45° field of view. Posterior pole photograph.
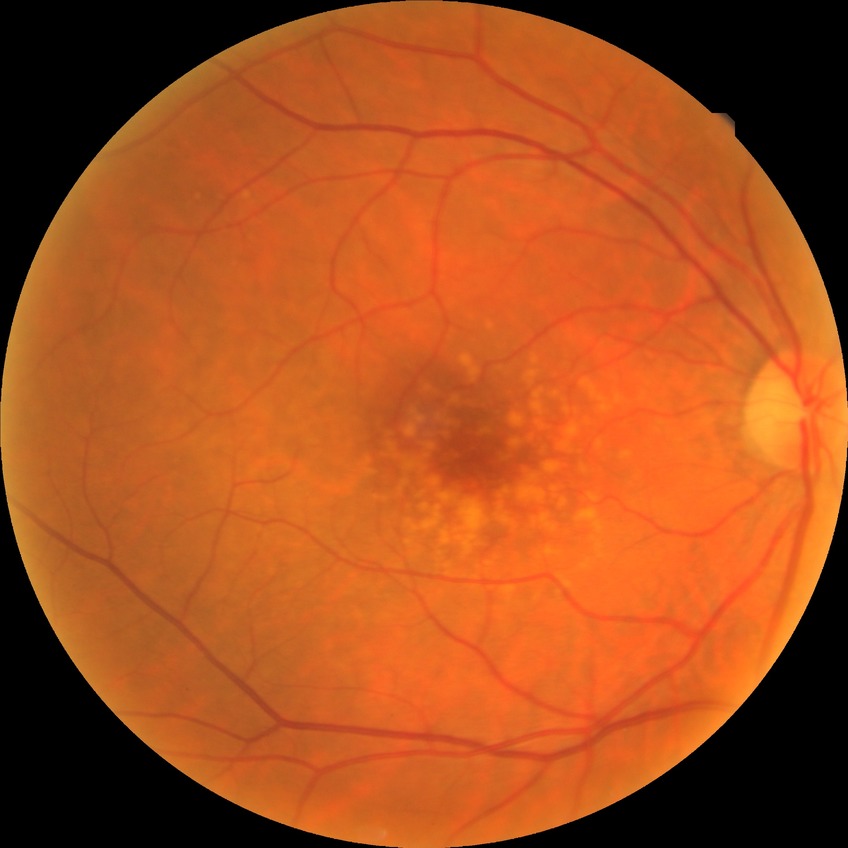

Diabetic retinopathy (DR) is NDR (no diabetic retinopathy).